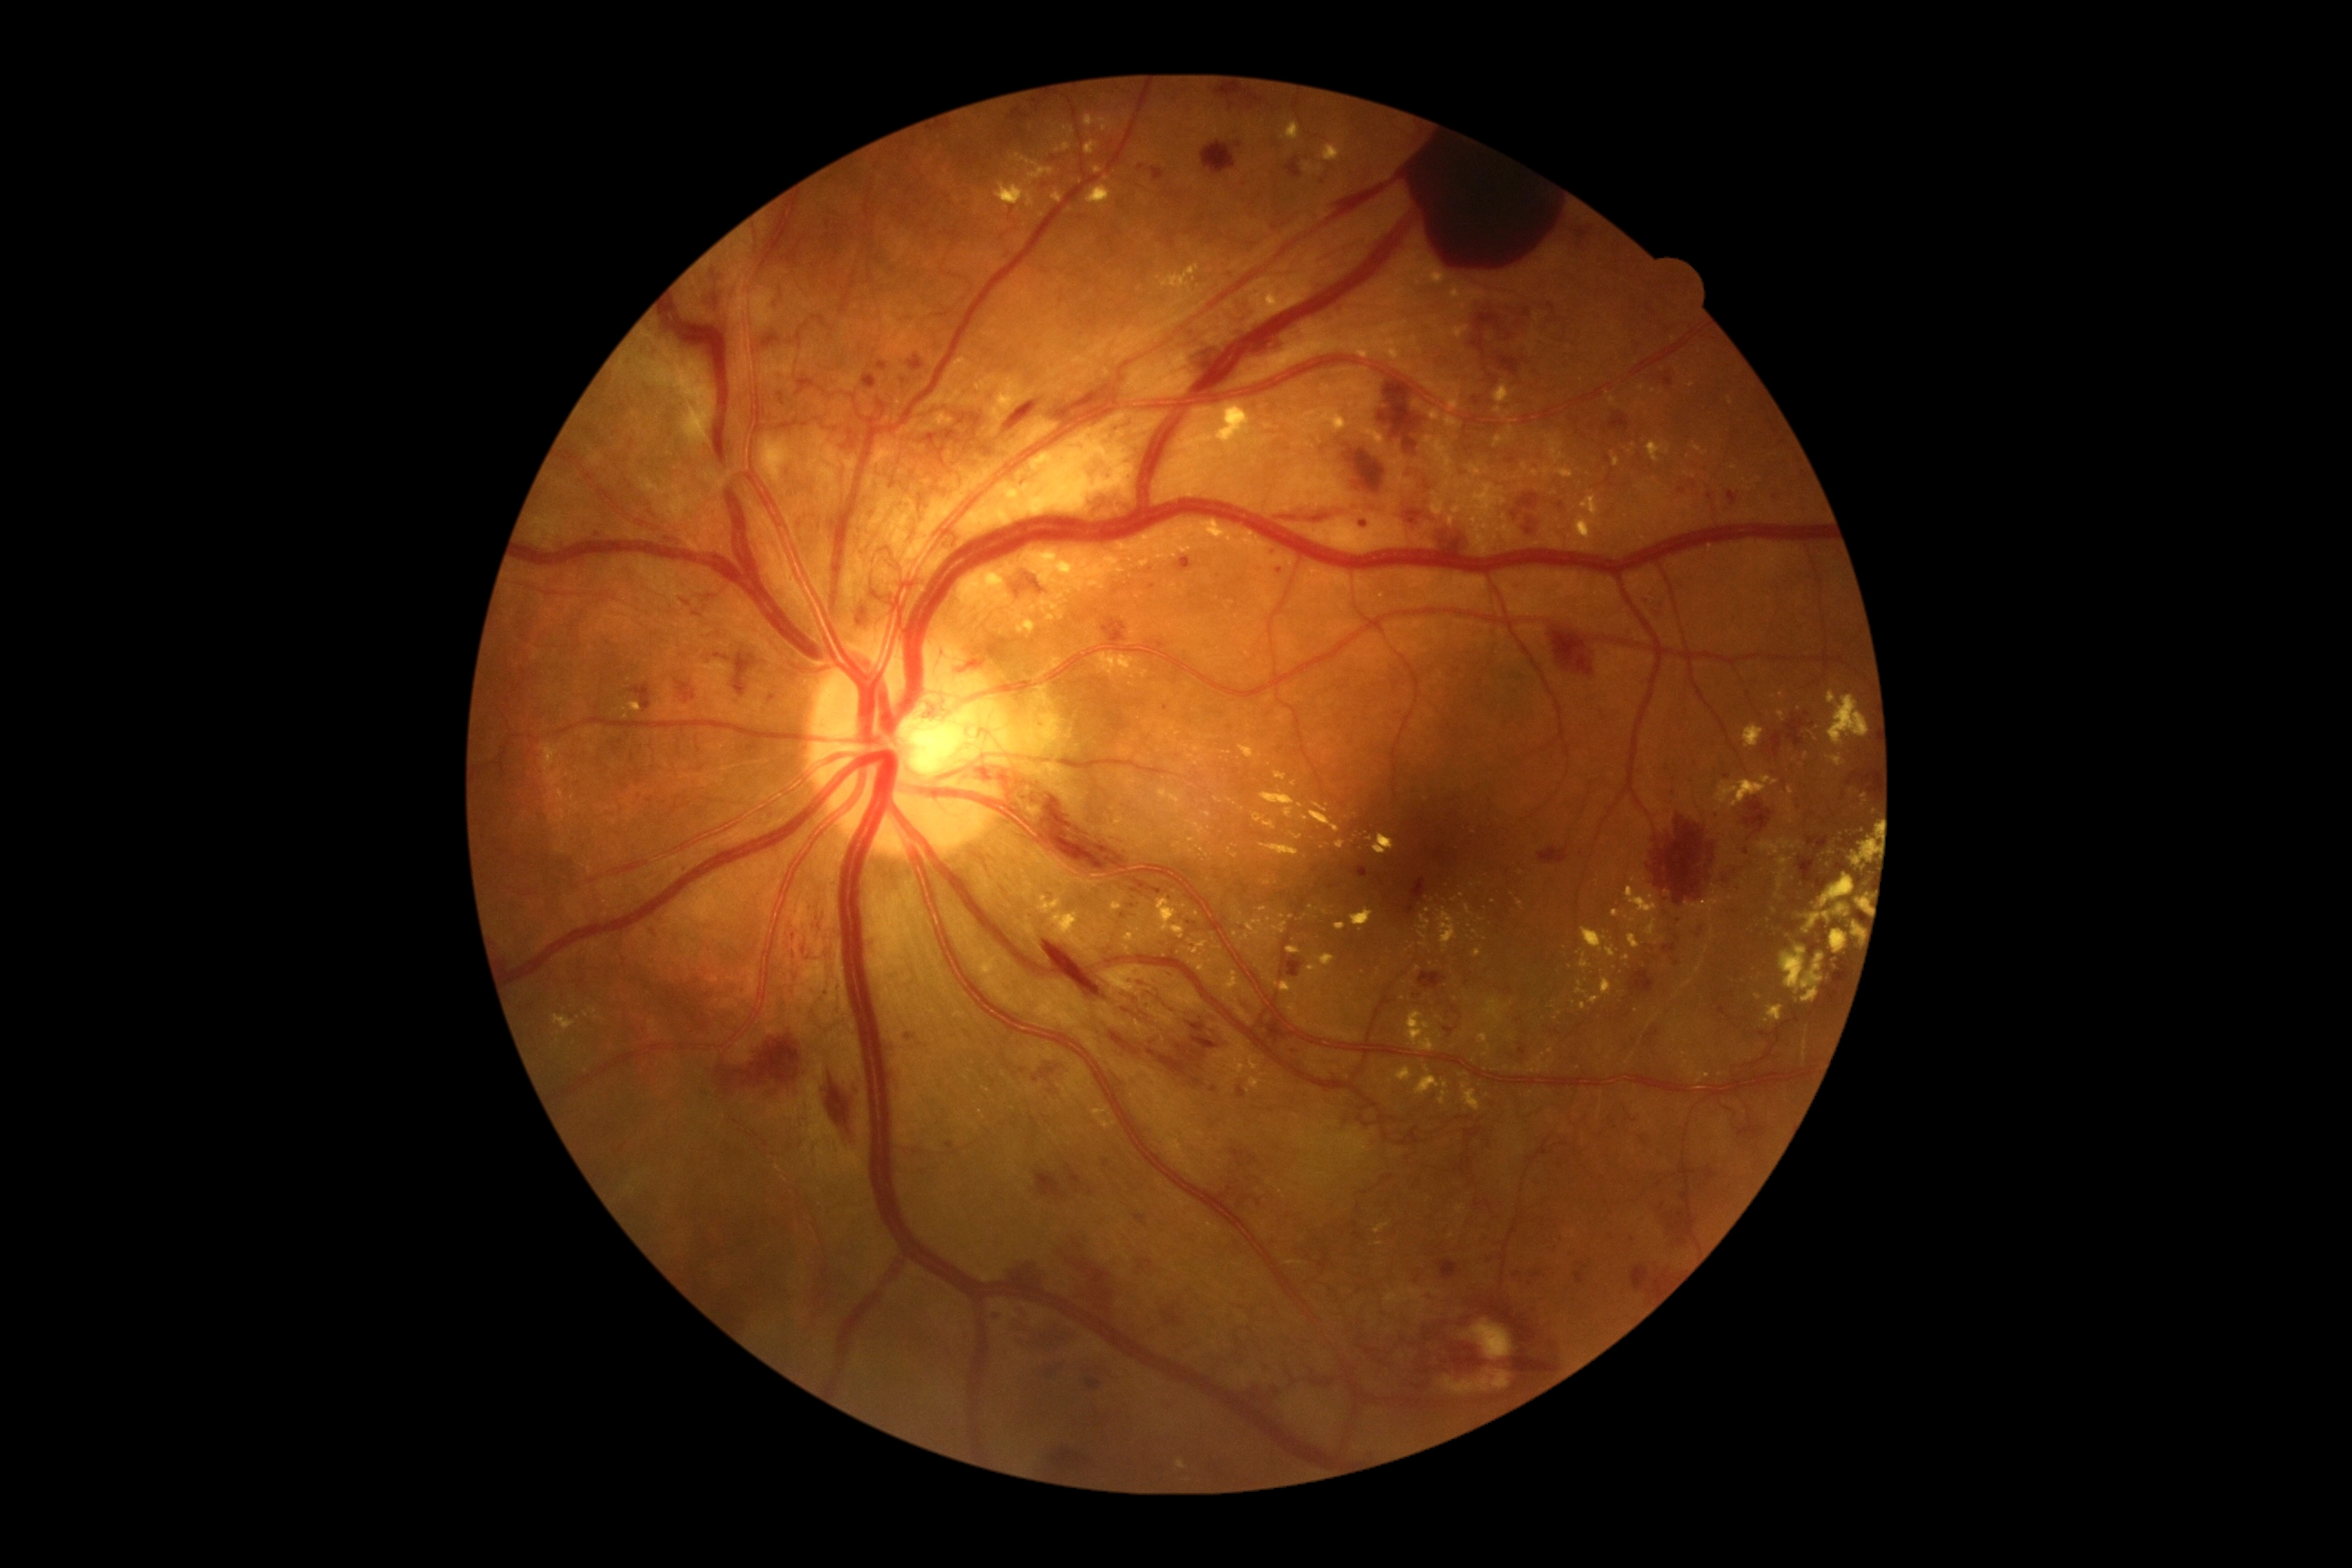

Diabetic retinopathy (DR): PDR (grade 4)
A subset of detected lesions:
microaneurysms (MAs): absent
hemorrhages (HEs) (partial): (x1=1438, y1=1259, x2=1460, y2=1280) | (x1=1514, y1=1271, x2=1522, y2=1277) | (x1=1215, y1=90, x2=1264, y2=110) | (x1=1139, y1=1259, x2=1153, y2=1271) | (x1=1507, y1=458, x2=1516, y2=466) | (x1=1101, y1=618, x2=1135, y2=651) | (x1=1166, y1=970, x2=1177, y2=977) | (x1=1792, y1=796, x2=1803, y2=810) | (x1=825, y1=1064, x2=856, y2=1152) | (x1=1322, y1=142, x2=1567, y2=270) | (x1=1496, y1=357, x2=1527, y2=377) | (x1=1756, y1=1030, x2=1774, y2=1037) | (x1=1808, y1=838, x2=1828, y2=850) | (x1=1348, y1=449, x2=1386, y2=493) | (x1=1847, y1=774, x2=1874, y2=787)
Small HEs near (1735, 911) | (1280, 570) | (1766, 747)
hard exudates (EXs) (partial): (x1=1250, y1=251, x2=1322, y2=322) | (x1=1612, y1=910, x2=1620, y2=917) | (x1=1429, y1=411, x2=1440, y2=422) | (x1=1464, y1=1084, x2=1482, y2=1112) | (x1=1043, y1=609, x2=1055, y2=622) | (x1=1727, y1=398, x2=1732, y2=406) | (x1=1351, y1=324, x2=1404, y2=360) | (x1=1215, y1=798, x2=1224, y2=805) | (x1=1284, y1=808, x2=1293, y2=819) | (x1=1850, y1=838, x2=1872, y2=870) | (x1=553, y1=1015, x2=576, y2=1032) | (x1=1023, y1=620, x2=1037, y2=634) | (x1=1685, y1=892, x2=1727, y2=923)
Small EXs near (1511, 1039) | (1042, 216) | (1306, 917) | (1551, 1052) | (1200, 849) | (1428, 911)
soft exudates (SEs): (x1=761, y1=351, x2=796, y2=387) | (x1=1462, y1=1318, x2=1514, y2=1360) | (x1=1438, y1=1369, x2=1511, y2=1395)